Color fundus image · 45° field of view — 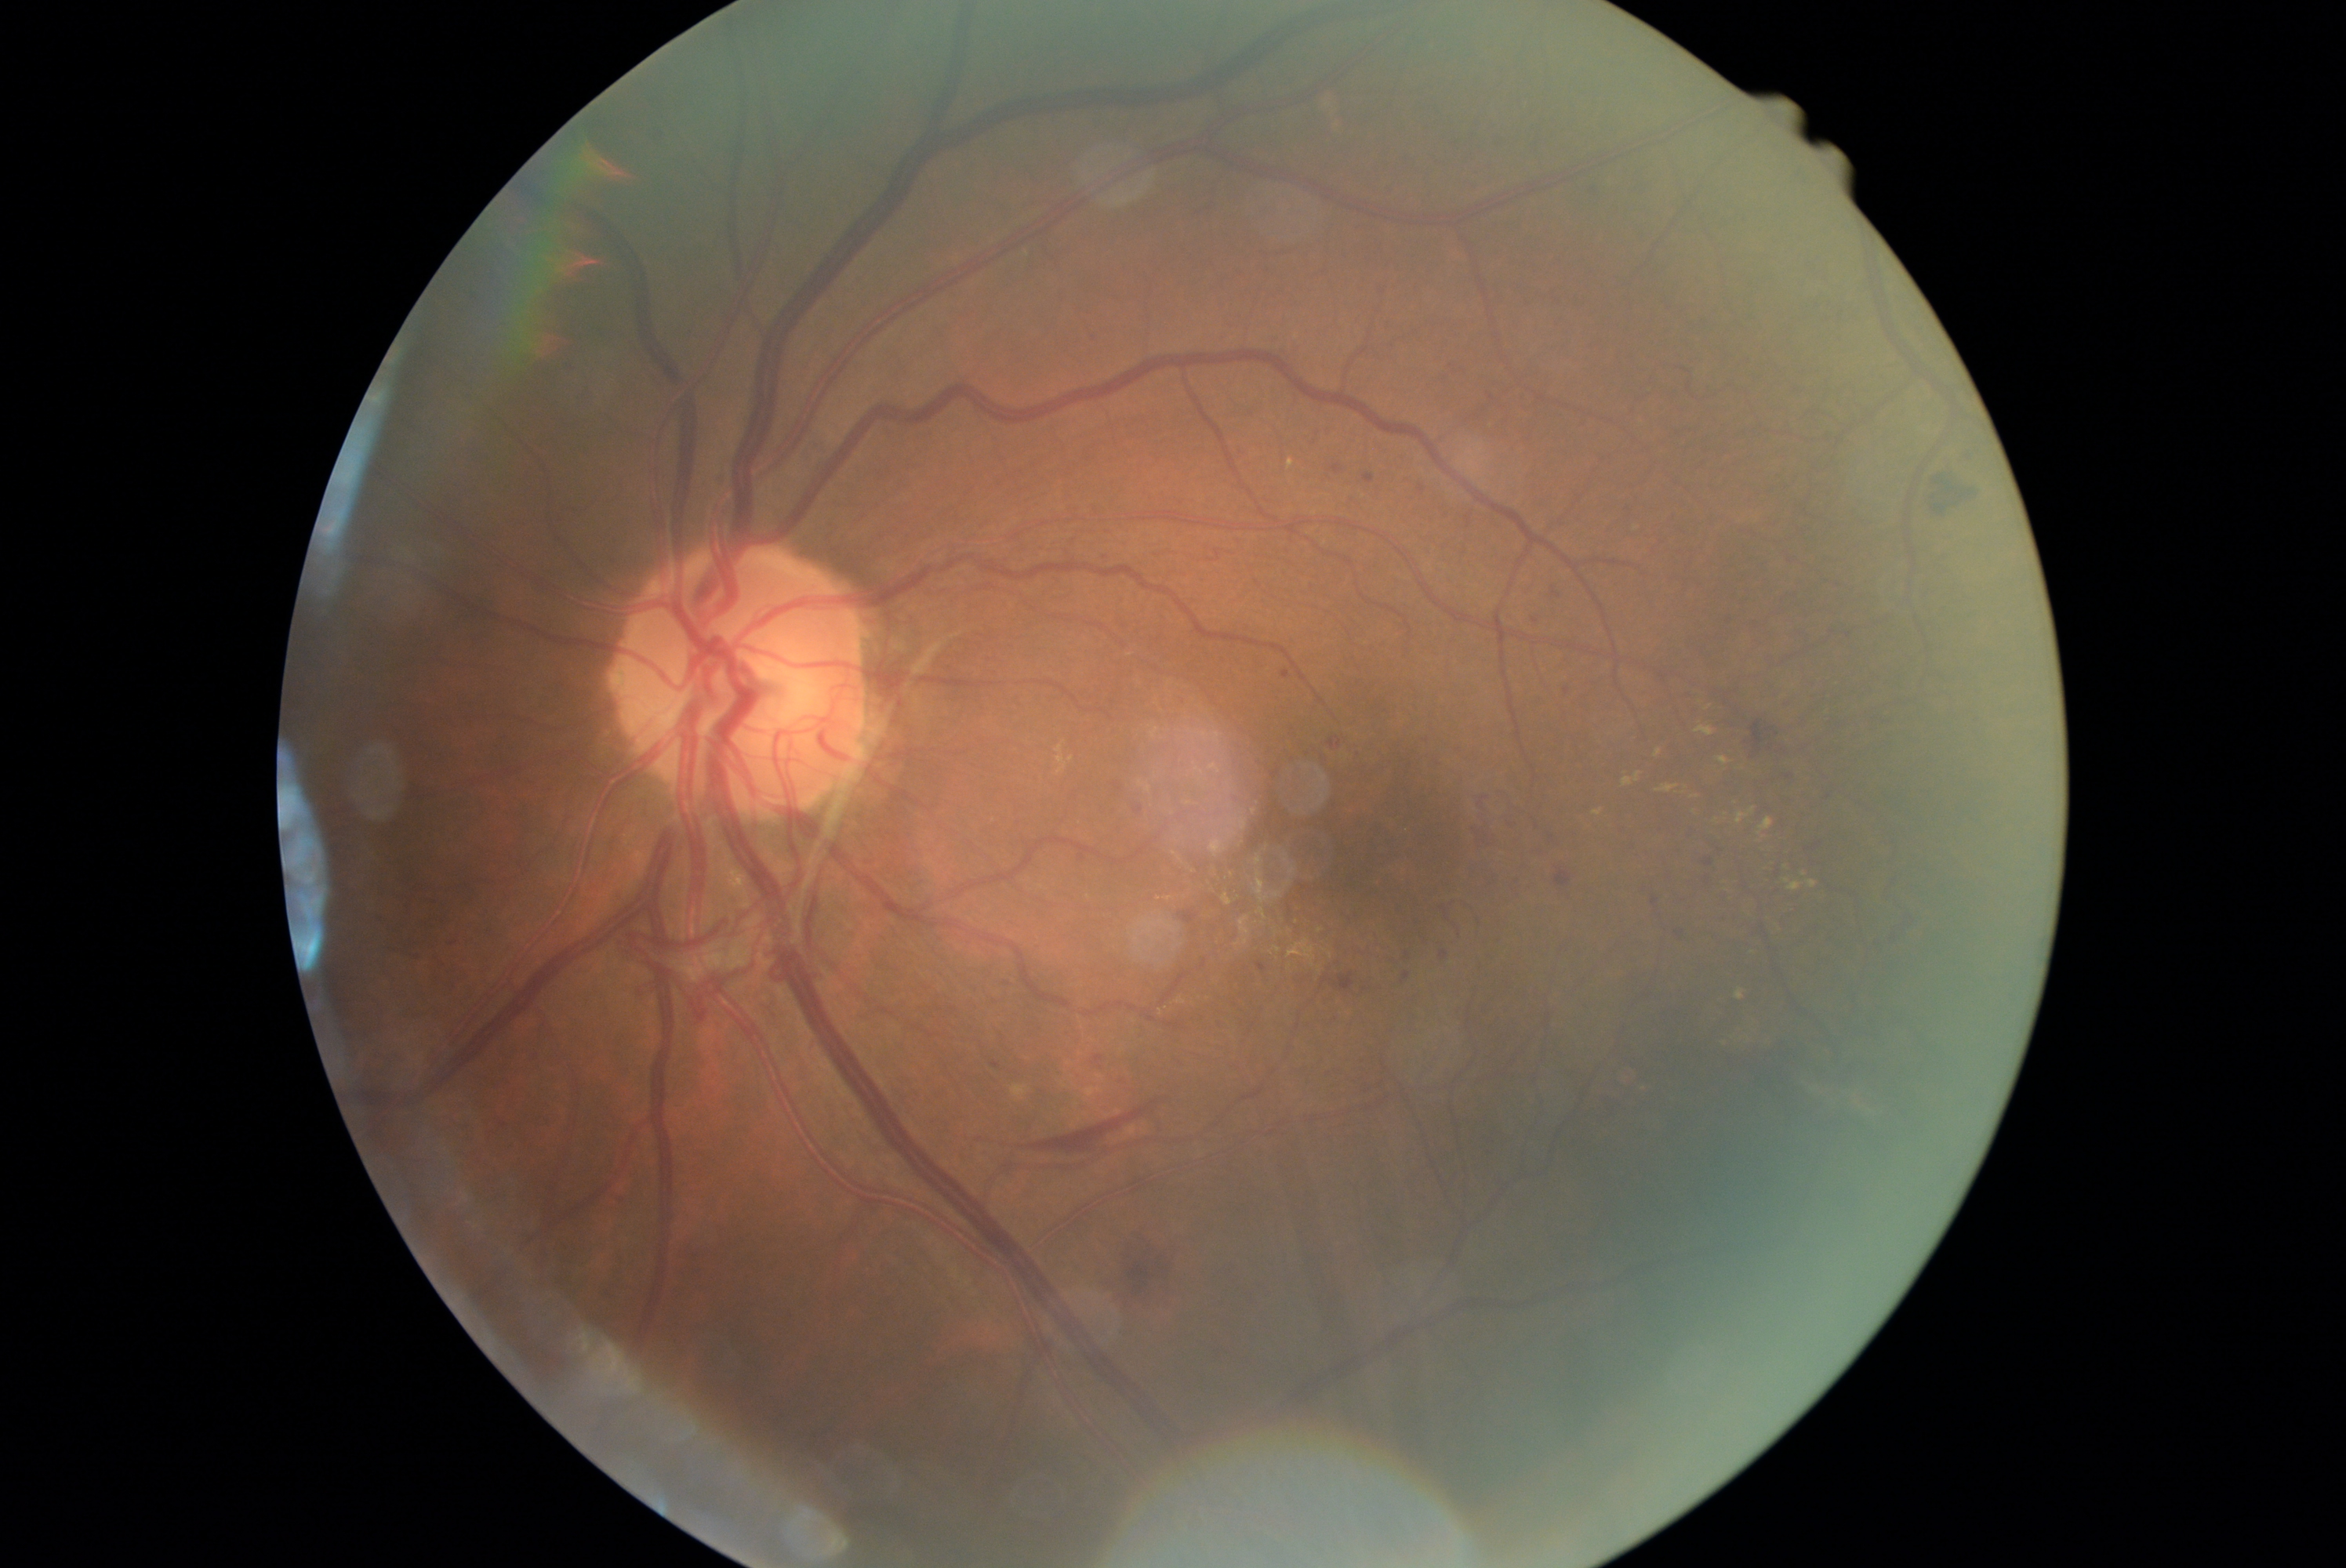
DR: proliferative diabetic retinopathy (grade 4).